Image size 1924x1556 · ultra-widefield fundus photograph · 200-degree field of view:
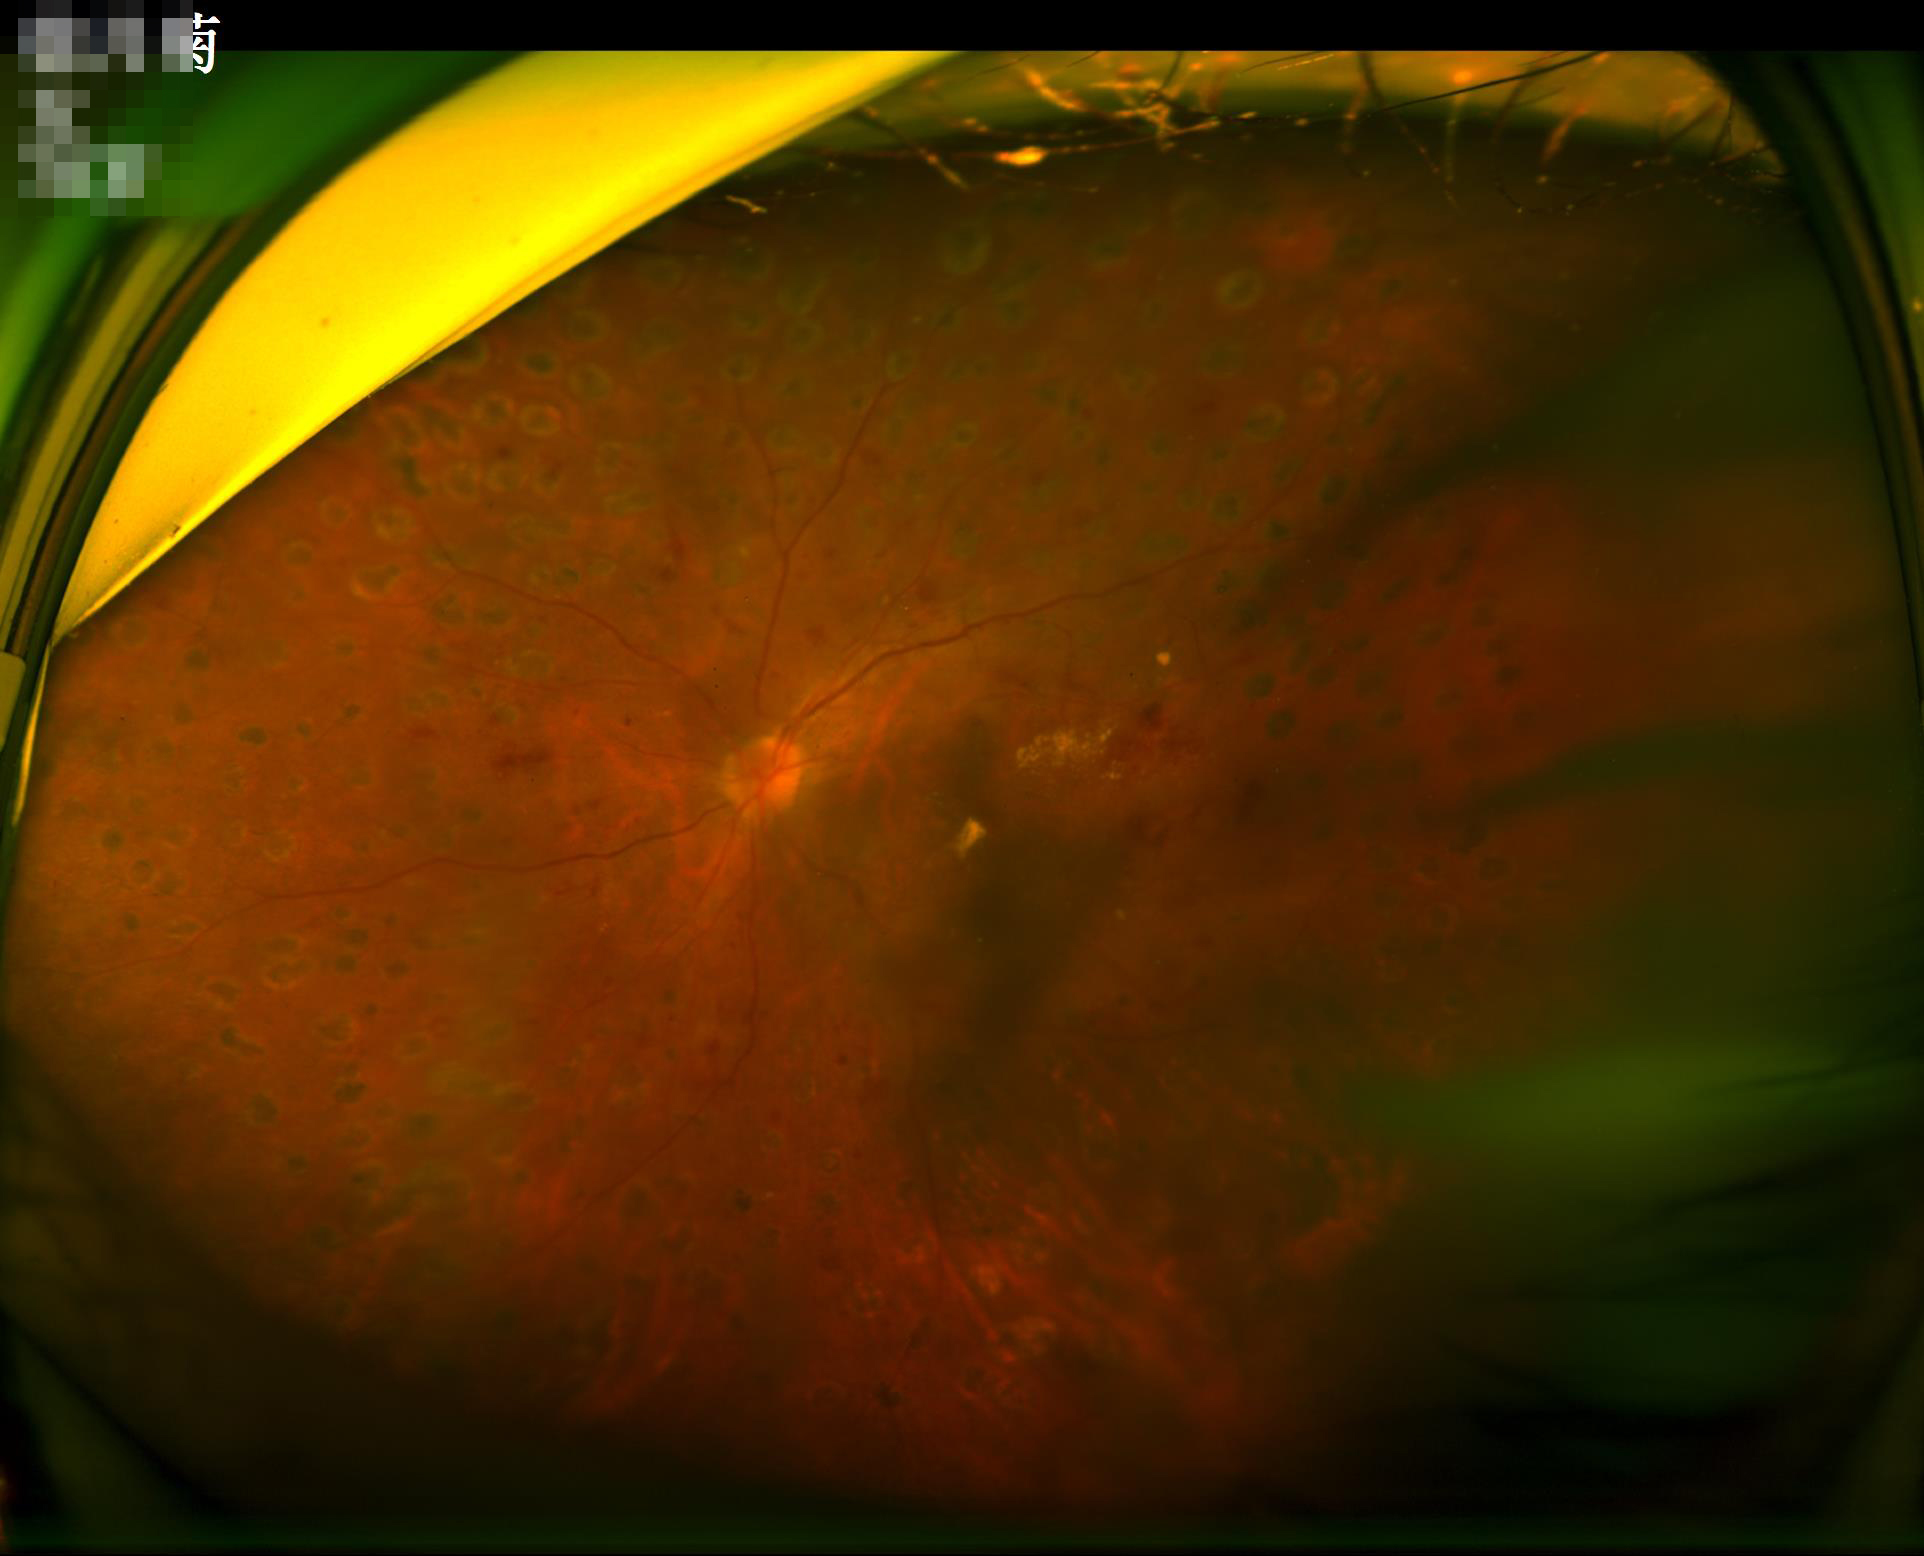

Image quality is suboptimal. Adequate contrast for distinguishing structures. Illumination is uneven. No noticeable blur.